Captured on a Nidek AFC-330 fundus camera
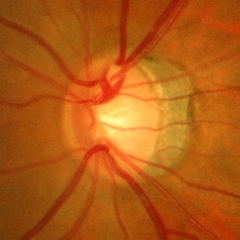 Assessment: advanced-stage glaucoma.